Image size 2048x1536 — 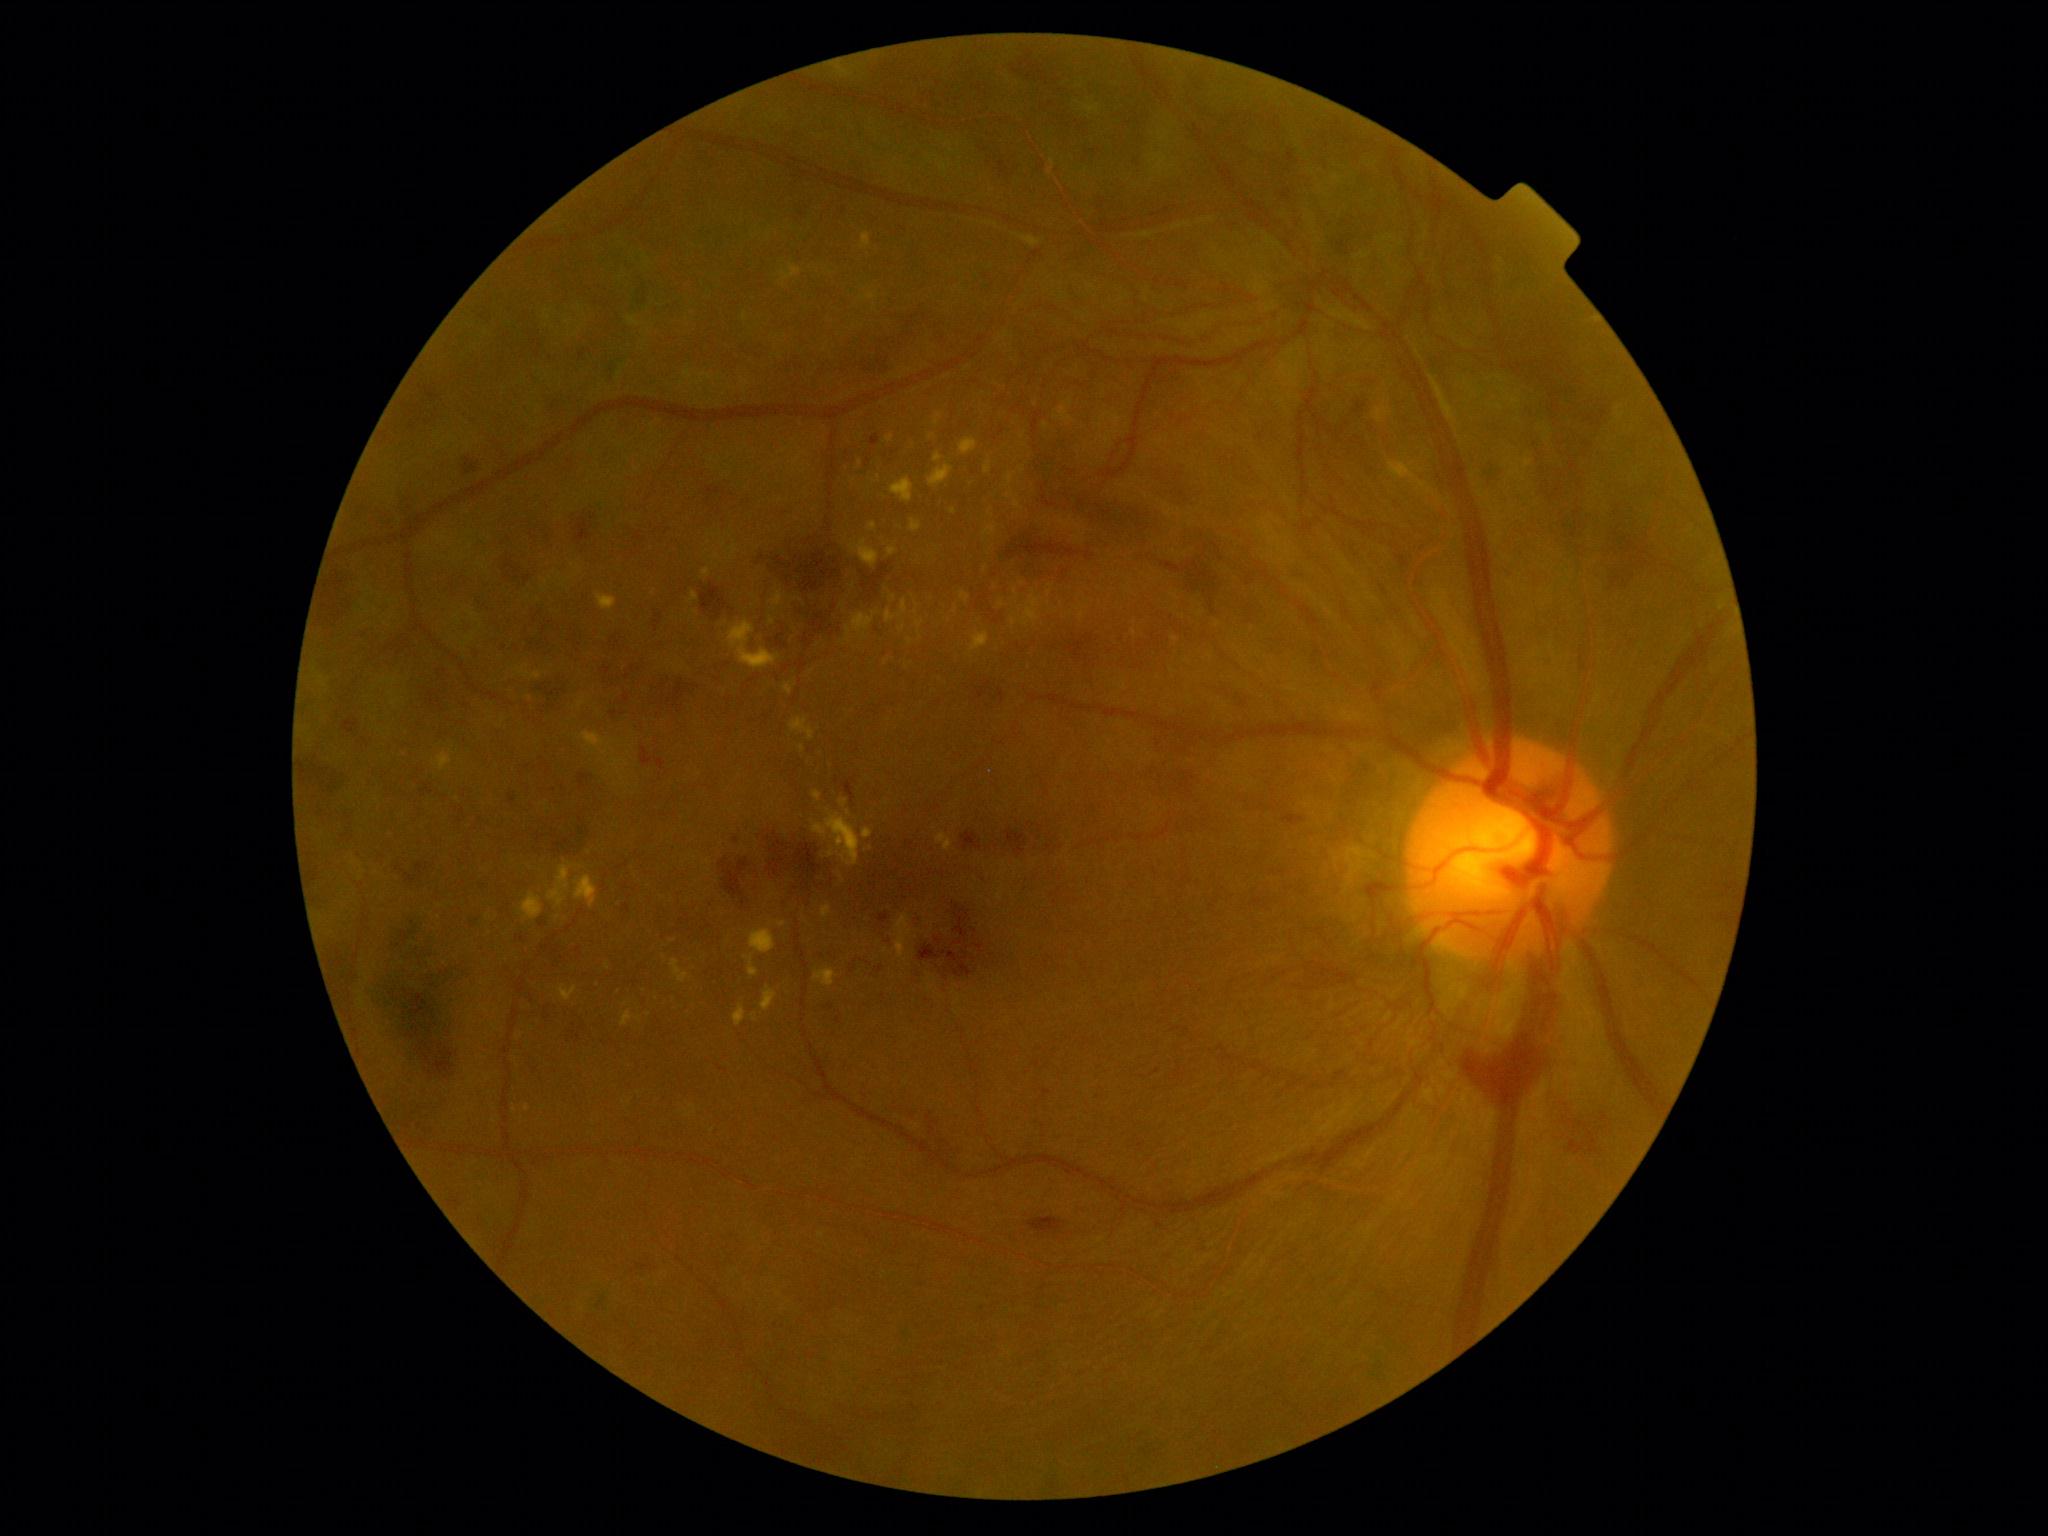 partial: true
dr_grade: 4
lesions:
  ex:
    - {"left": 730, "top": 546, "right": 739, "bottom": 560}
    - {"left": 761, "top": 987, "right": 779, "bottom": 1012}
    - {"left": 782, "top": 265, "right": 802, "bottom": 282}
    - {"left": 849, "top": 540, "right": 879, "bottom": 569}
    - {"left": 685, "top": 1105, "right": 697, "bottom": 1118}
    - {"left": 999, "top": 600, "right": 1005, "bottom": 609}
    - {"left": 985, "top": 461, "right": 992, "bottom": 474}
    - {"left": 734, "top": 1005, "right": 746, "bottom": 1027}
    - {"left": 813, "top": 790, "right": 822, "bottom": 802}
    - {"left": 790, "top": 717, "right": 816, "bottom": 740}
    - {"left": 829, "top": 848, "right": 836, "bottom": 858}
  ex_small:
    - x=771 y=924
    - x=673 y=940
    - x=1046 y=426
    - x=695 y=612
    - x=773 y=894
    - x=361 y=879
    - x=812 y=671
    - x=842 y=642